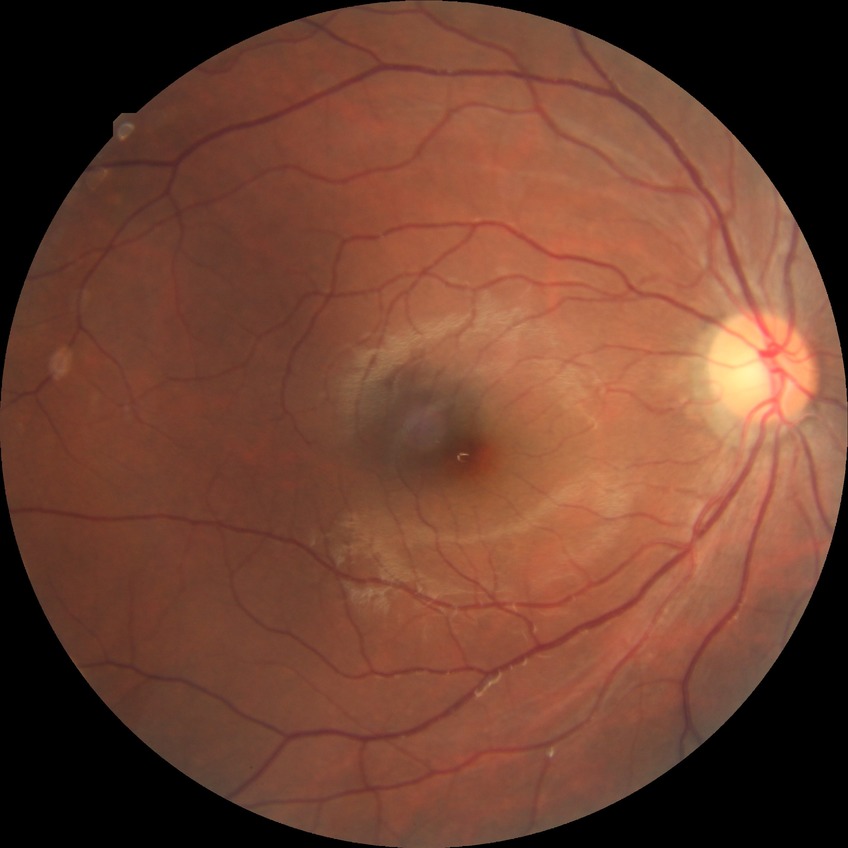

  davis_grade: no diabetic retinopathy